848x848px · nonmydriatic · modified Davis grading · NIDEK AFC-230 fundus camera
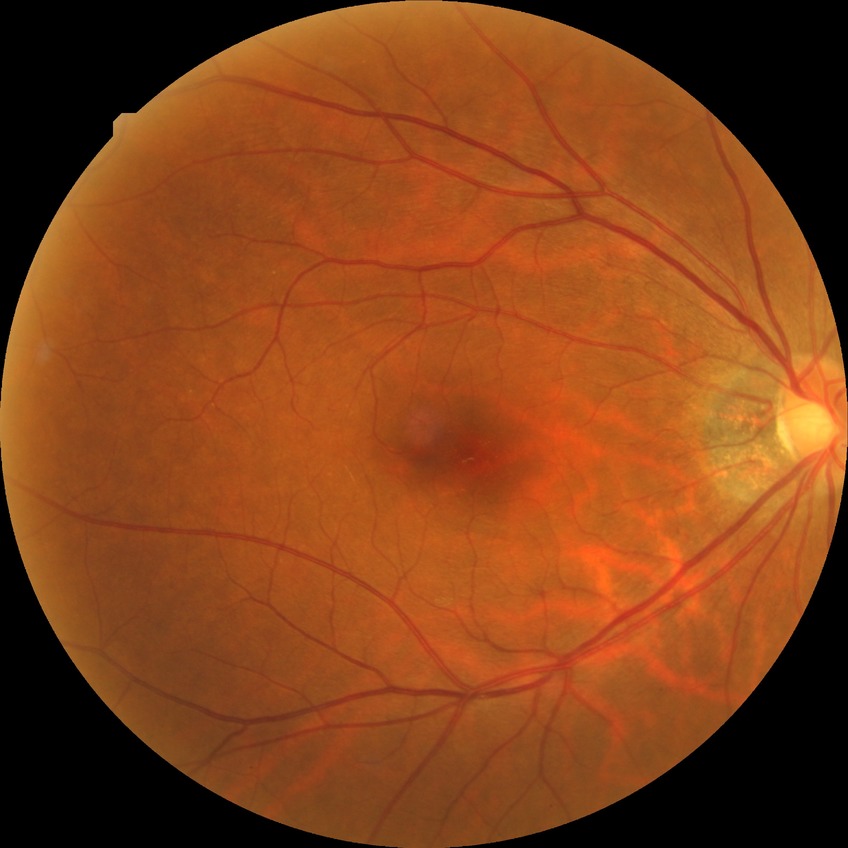 Davis grade: NDR.